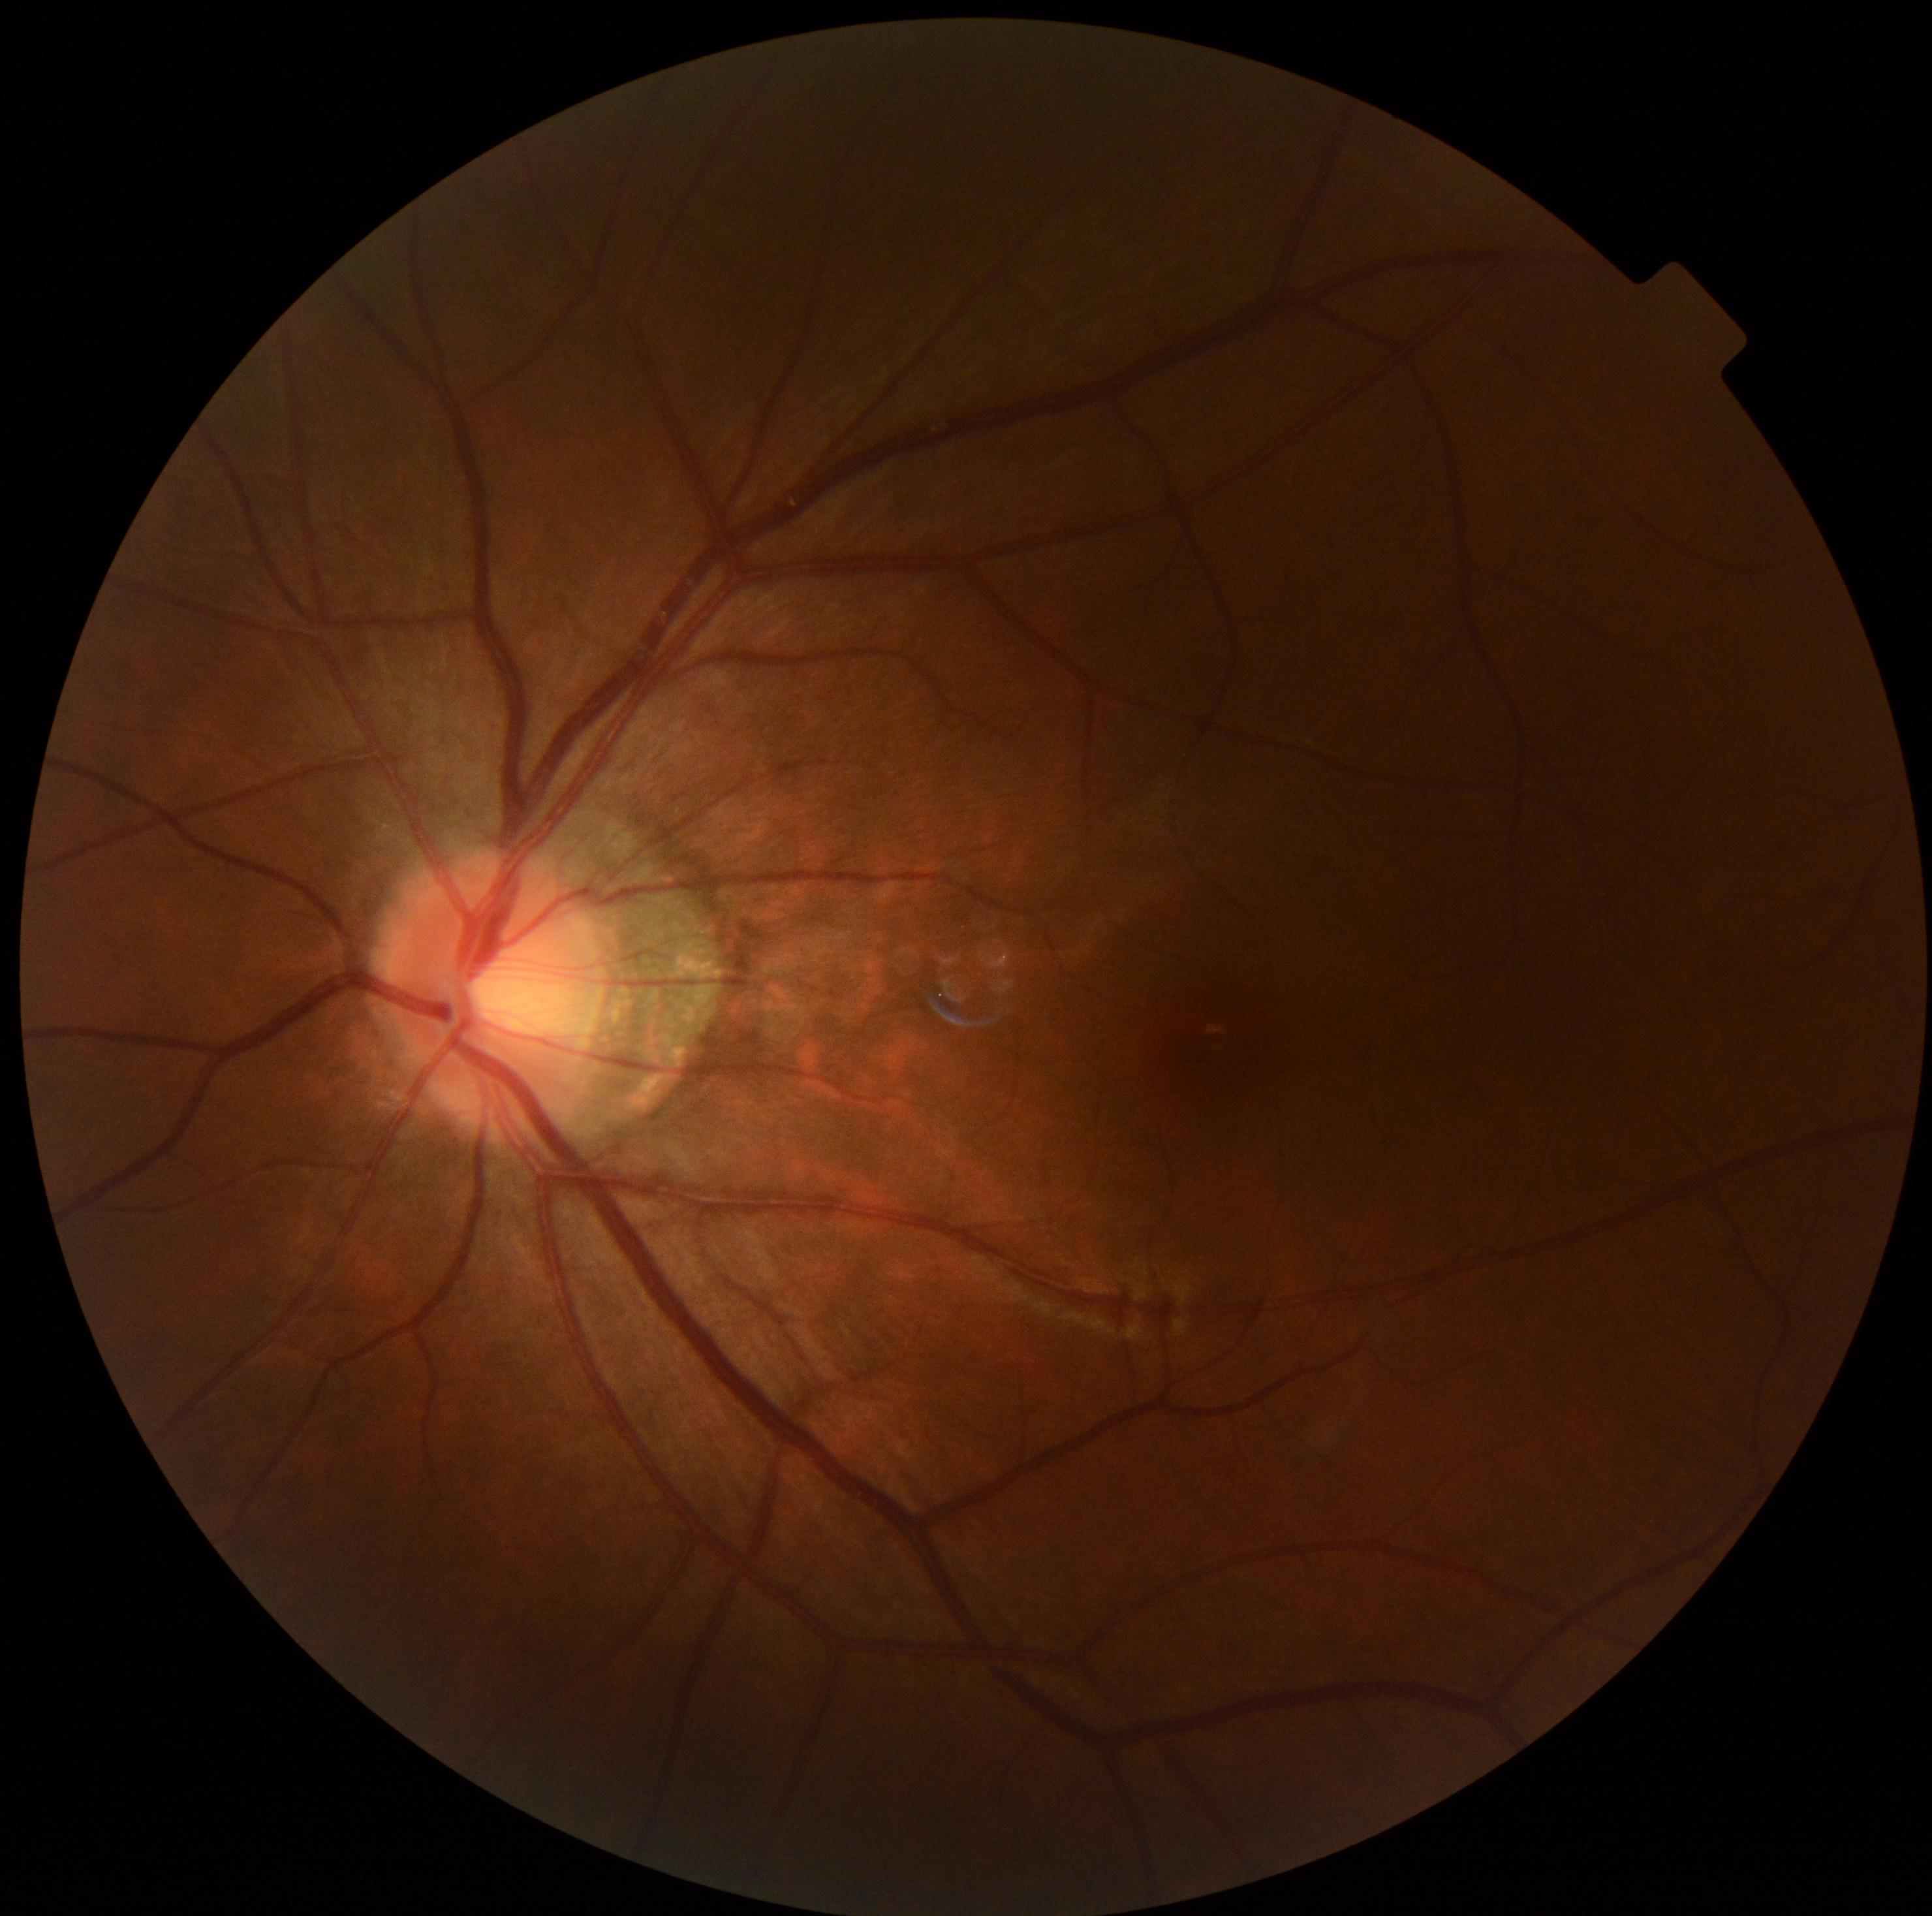

Diabetic retinopathy (DR): grade 0 (no apparent retinopathy).